Image size 1380x1382 · color fundus photograph · FOV: 45 degrees
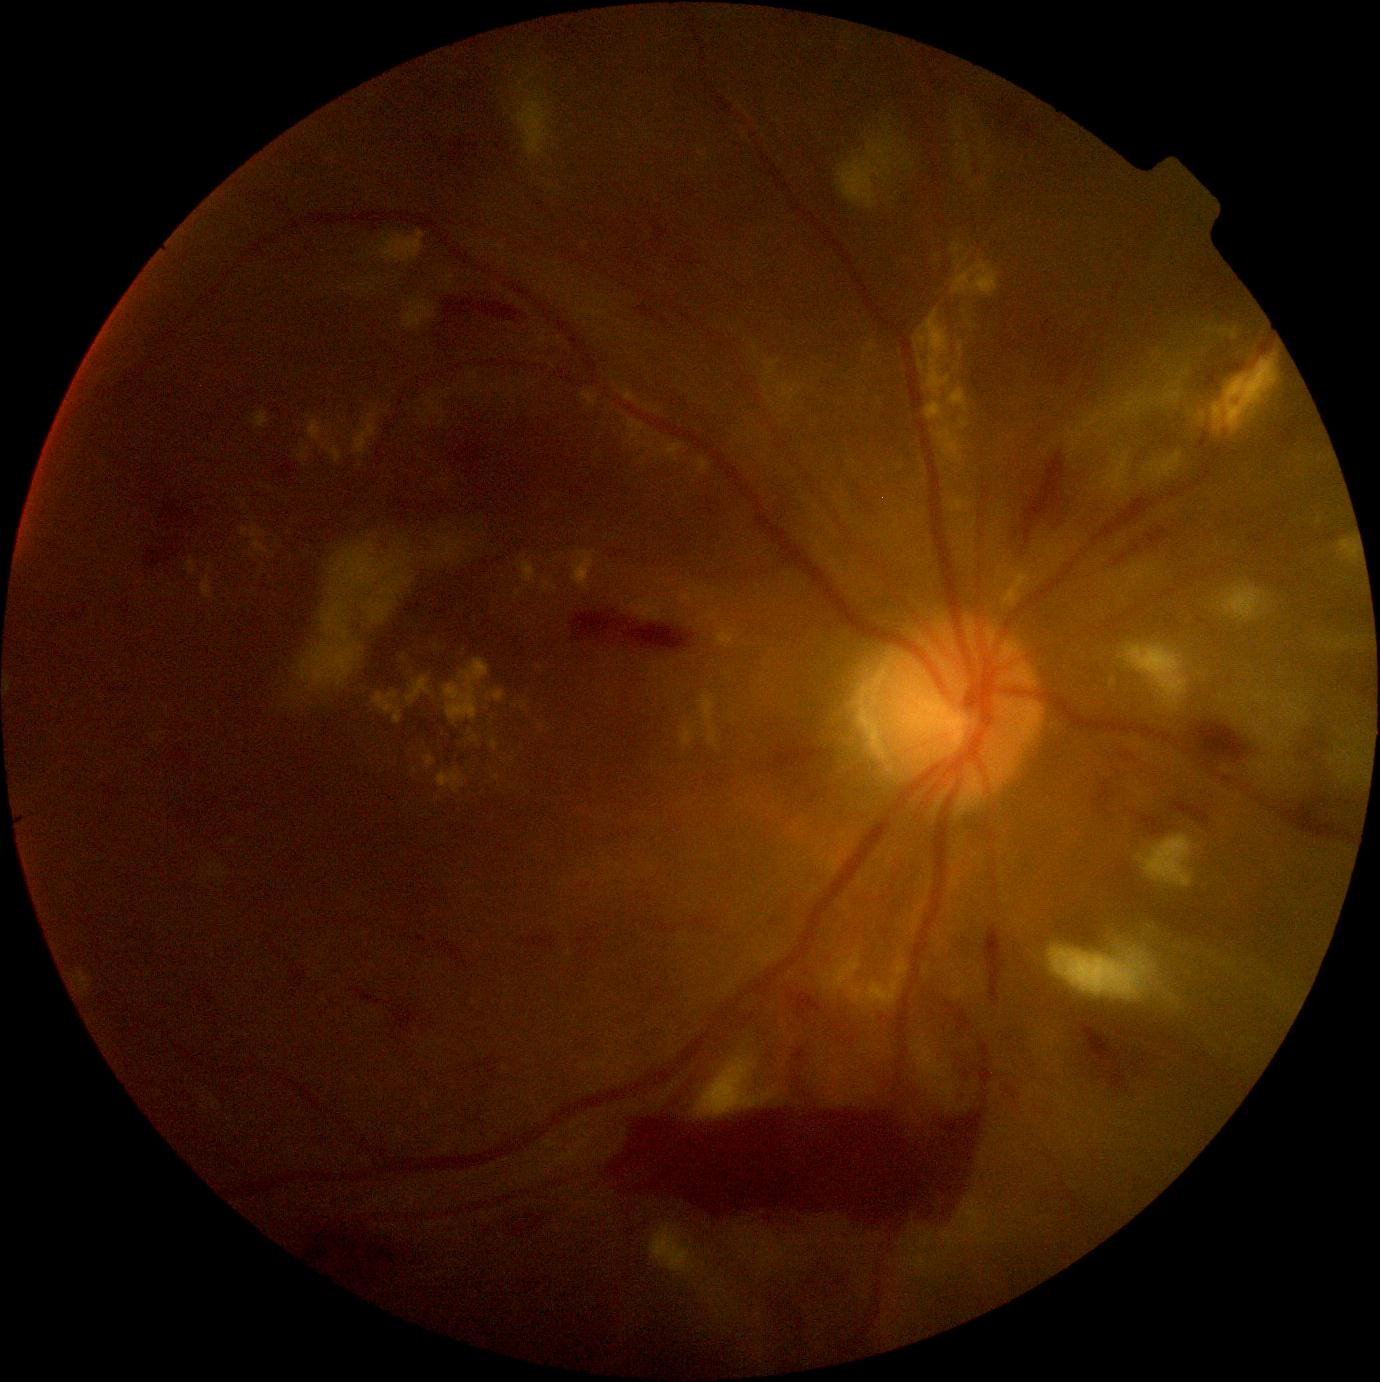

Retinopathy grade is 4/4. No microaneurysms identified. Hemorrhages present at box=[1082, 1024, 1125, 1090], box=[1284, 798, 1361, 843], box=[1120, 747, 1147, 770], box=[944, 998, 993, 1094], box=[564, 1094, 994, 1231], box=[1105, 517, 1177, 571], box=[1192, 723, 1249, 765], box=[1094, 785, 1111, 804], box=[769, 749, 831, 769], box=[1024, 451, 1067, 545], box=[781, 988, 832, 1040], box=[572, 614, 696, 653], box=[781, 1045, 815, 1090], box=[1142, 816, 1167, 838], box=[985, 929, 1004, 1003], box=[1173, 804, 1210, 827]. Soft exudates (partial list) at box=[838, 126, 893, 210], box=[1287, 709, 1305, 724], box=[519, 83, 530, 94], box=[1137, 835, 1194, 889], box=[1075, 429, 1085, 439], box=[1218, 581, 1272, 623], box=[1339, 541, 1358, 560], box=[1149, 451, 1183, 482], box=[1345, 774, 1351, 785], box=[1068, 429, 1074, 437], box=[1250, 769, 1254, 777], box=[293, 524, 478, 696]. Additional small soft exudates near (x=904, y=164), (x=1277, y=753), (x=1243, y=701), (x=1287, y=782), (x=1096, y=491), (x=1146, y=470). Hard exudates (partial list) at box=[628, 418, 645, 443], box=[471, 736, 479, 743], box=[405, 677, 432, 707], box=[377, 231, 426, 265], box=[254, 409, 269, 429], box=[647, 444, 655, 449], box=[446, 274, 455, 292], box=[373, 692, 403, 724], box=[682, 728, 695, 747], box=[864, 340, 878, 354], box=[958, 342, 963, 359], box=[913, 309, 969, 466]. Additional small hard exudates near (x=542, y=725), (x=173, y=596), (x=937, y=256), (x=649, y=406), (x=540, y=668).